1932x1932
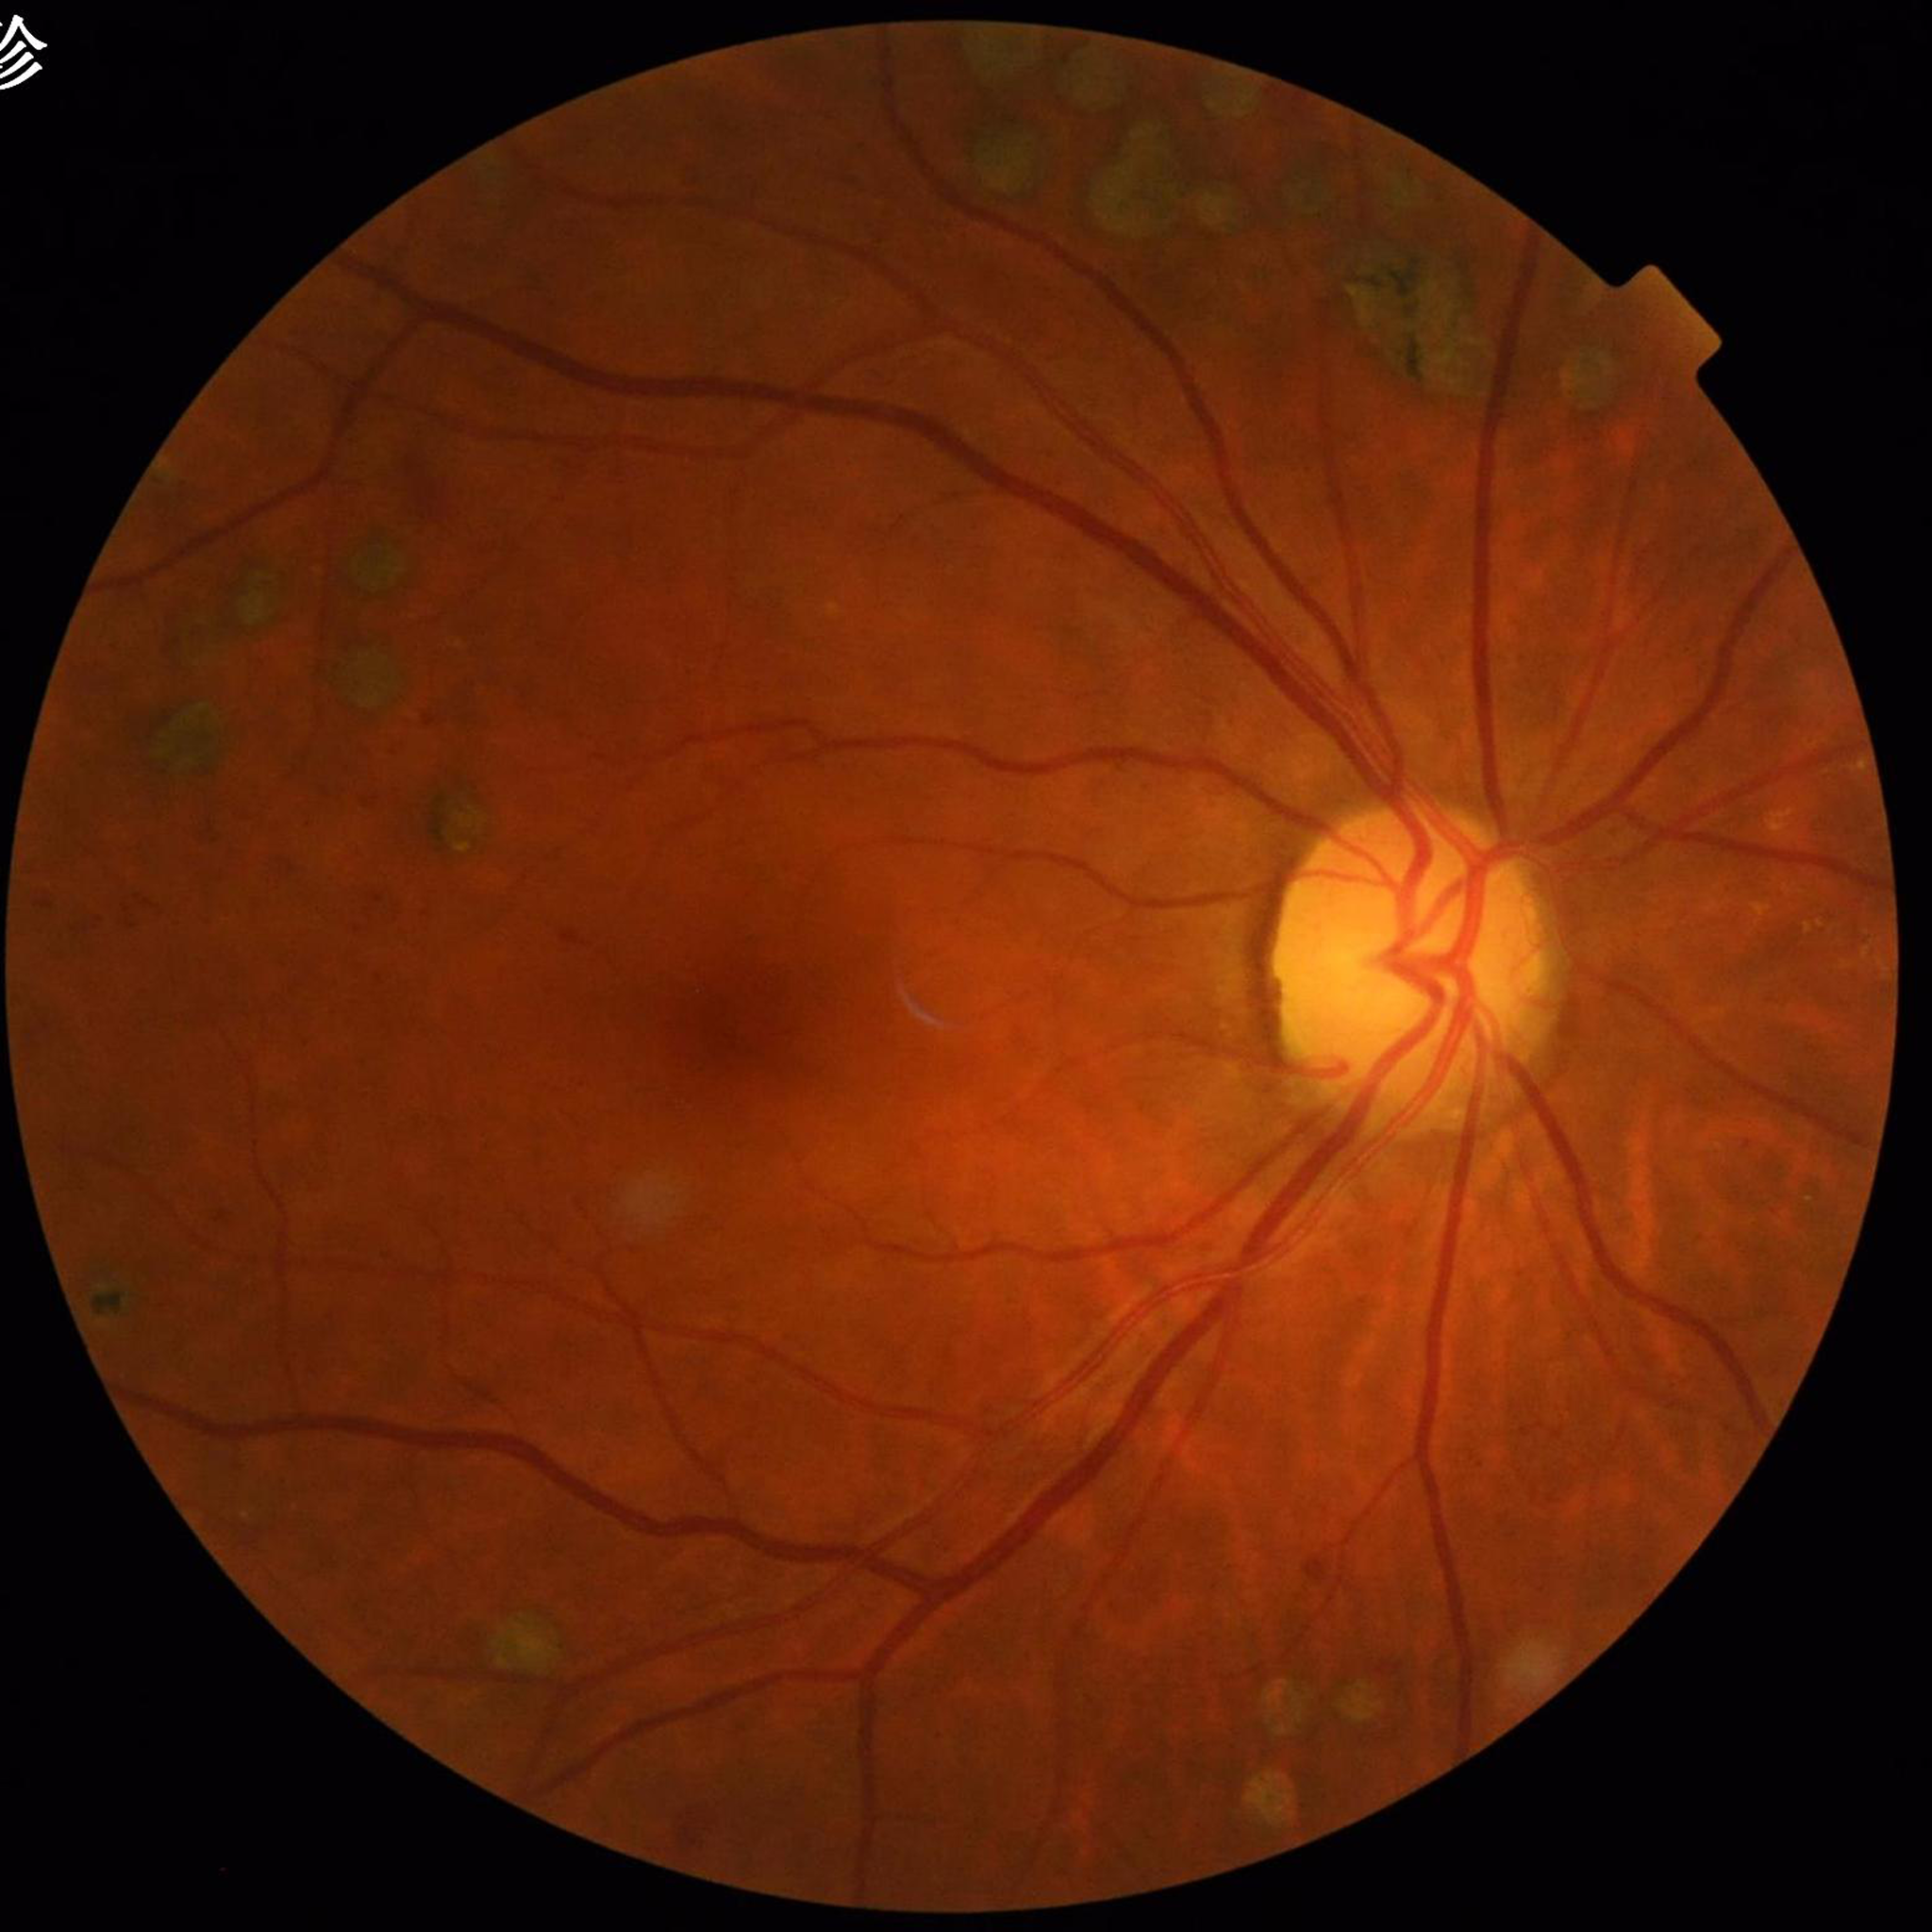
{"diagnosis": "diabetic retinopathy (DR)"}